2352 x 1568 pixels; FOV: 45 degrees
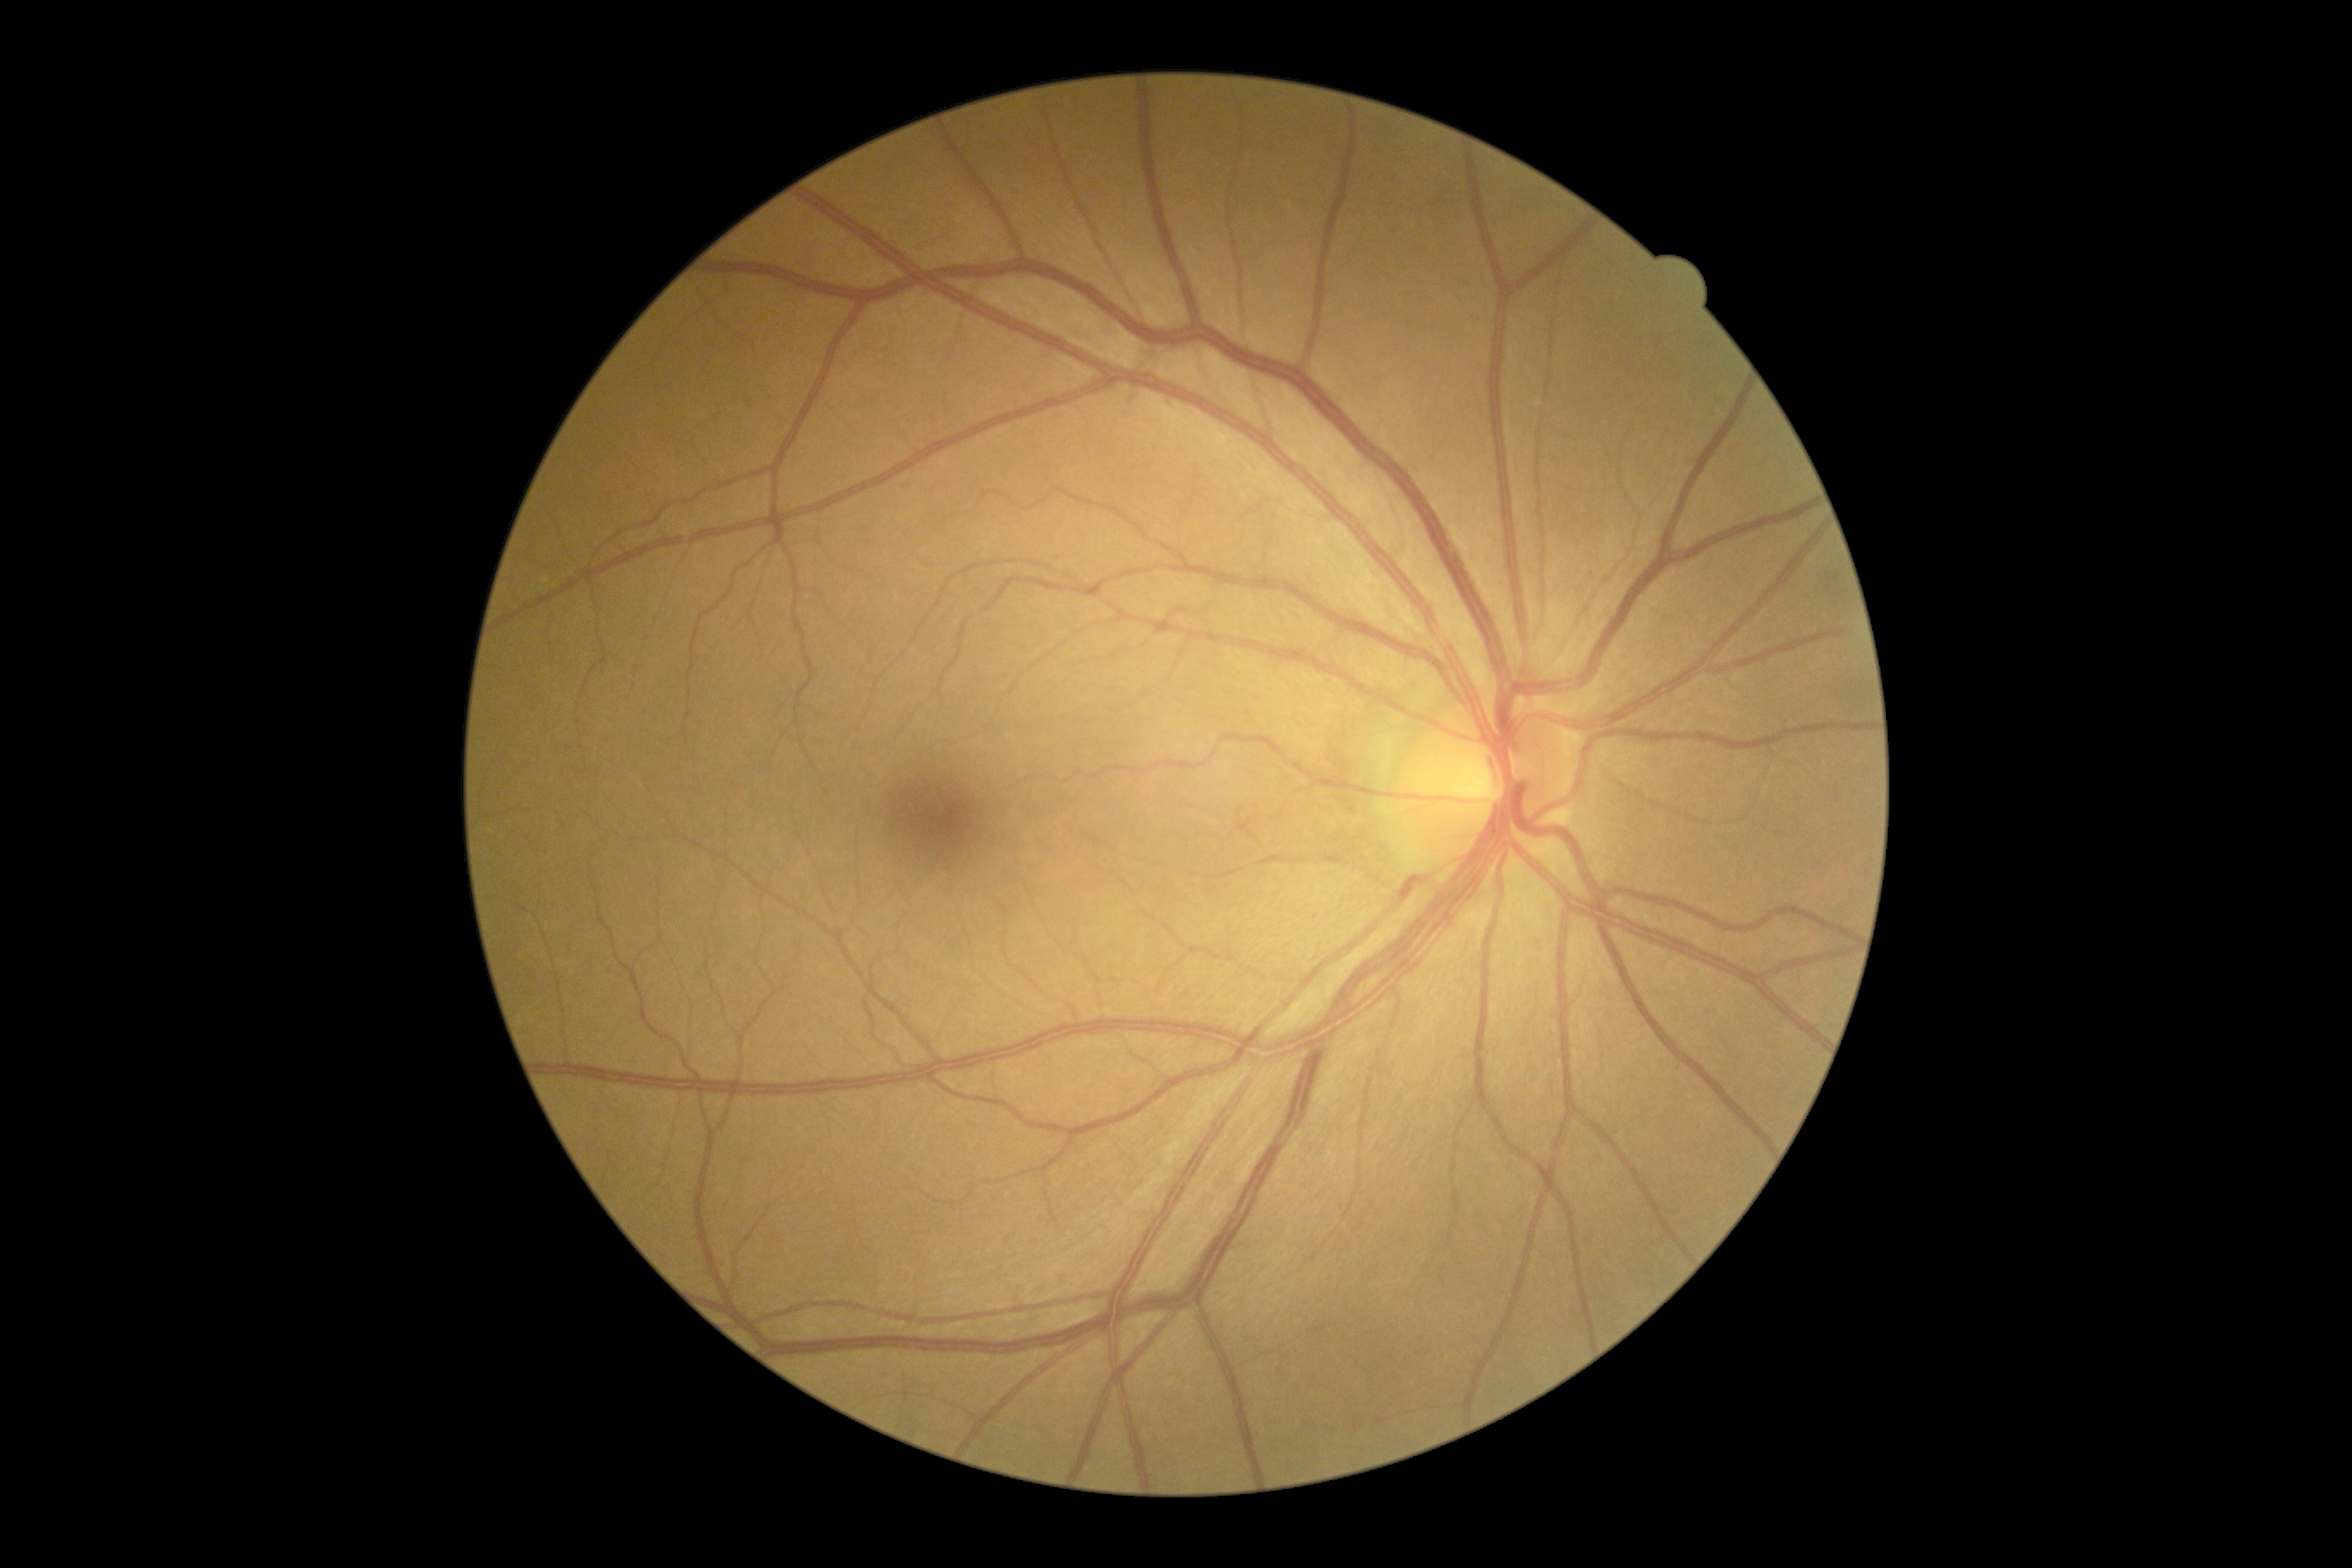 Diabetic retinopathy grade: 0.